Wide-field fundus photograph from neonatal ROP screening · 640 x 480 pixels
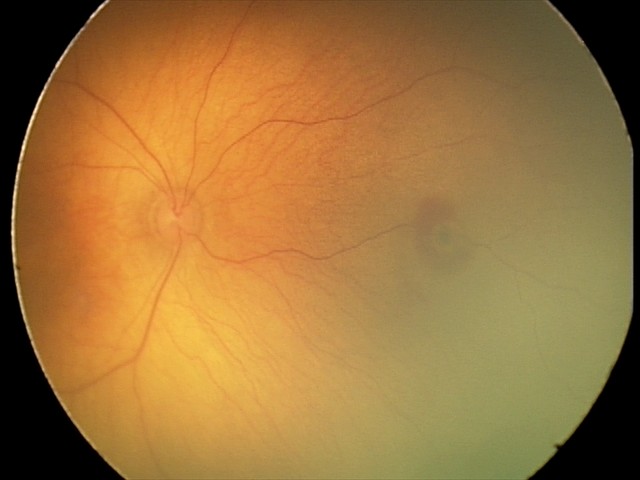

Diagnosis from this screening exam: retinal hemorrhages.